Pediatric wide-field fundus photograph
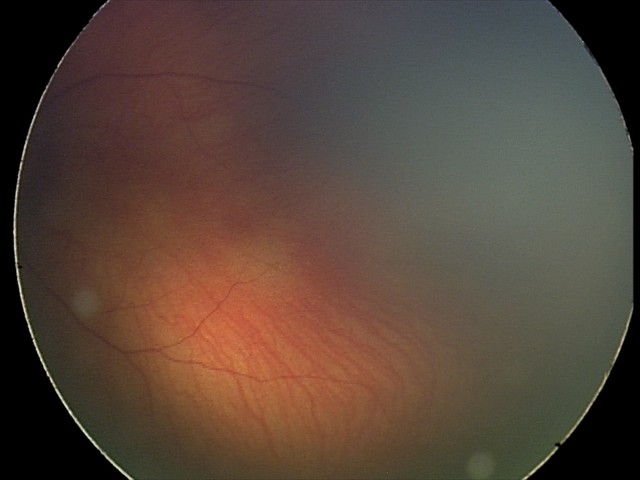
Diagnosis = retinal hemorrhages.